Ultra-widefield fundus mosaic, image size 1924x1556 — 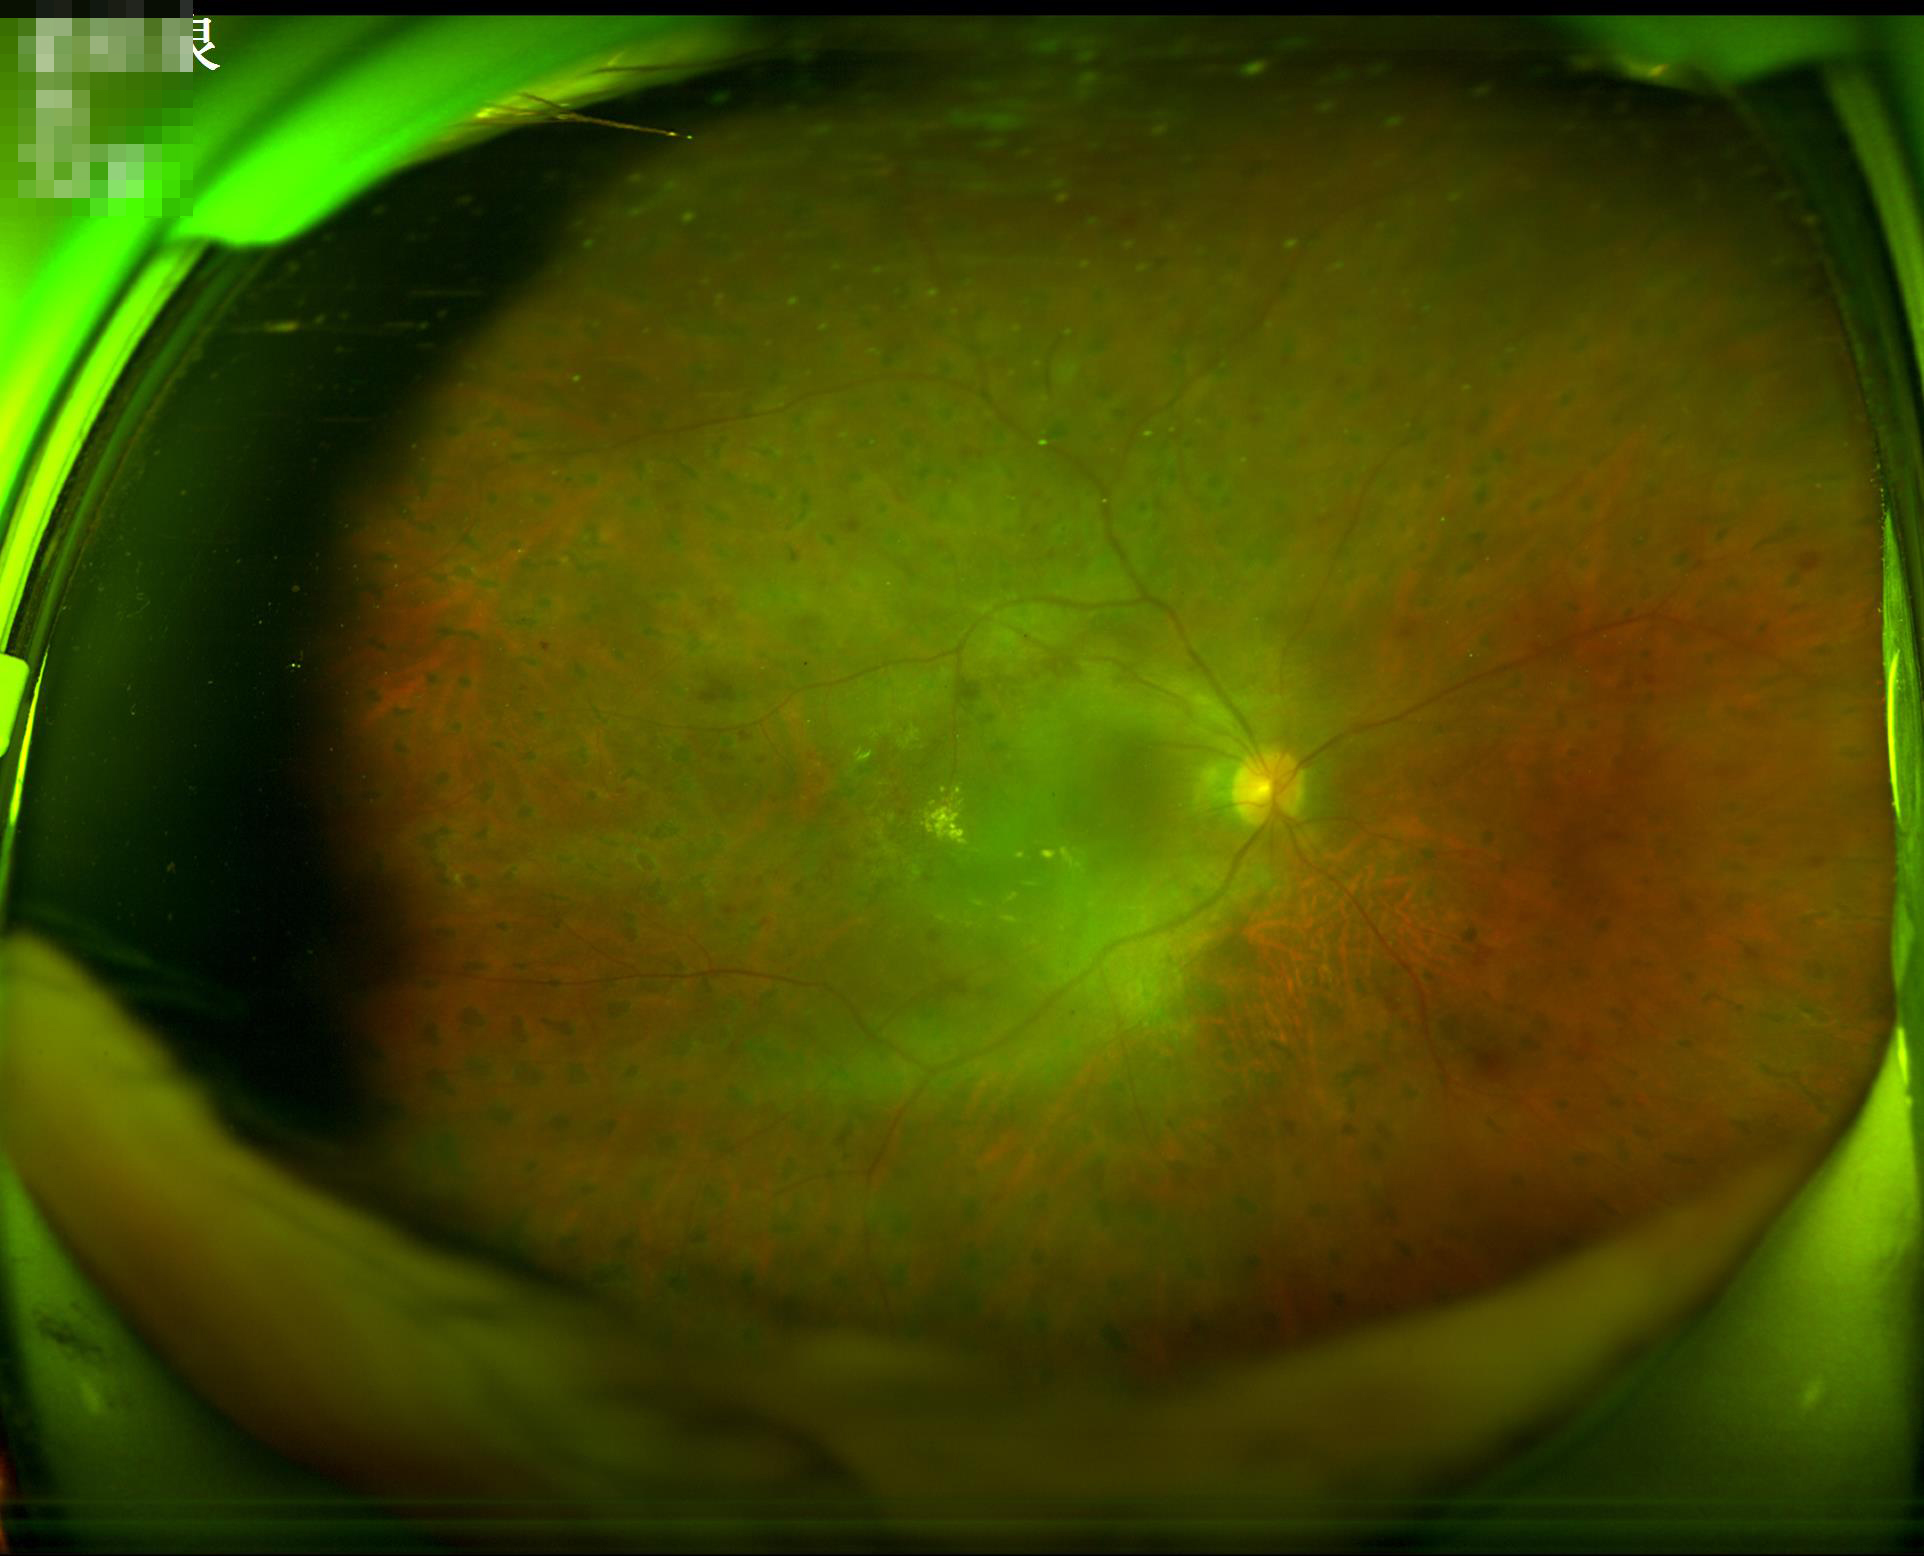
Sharpness: good
Illumination: uneven
Overall: suboptimal
Contrast: adequate